CFP. 1659x2212: 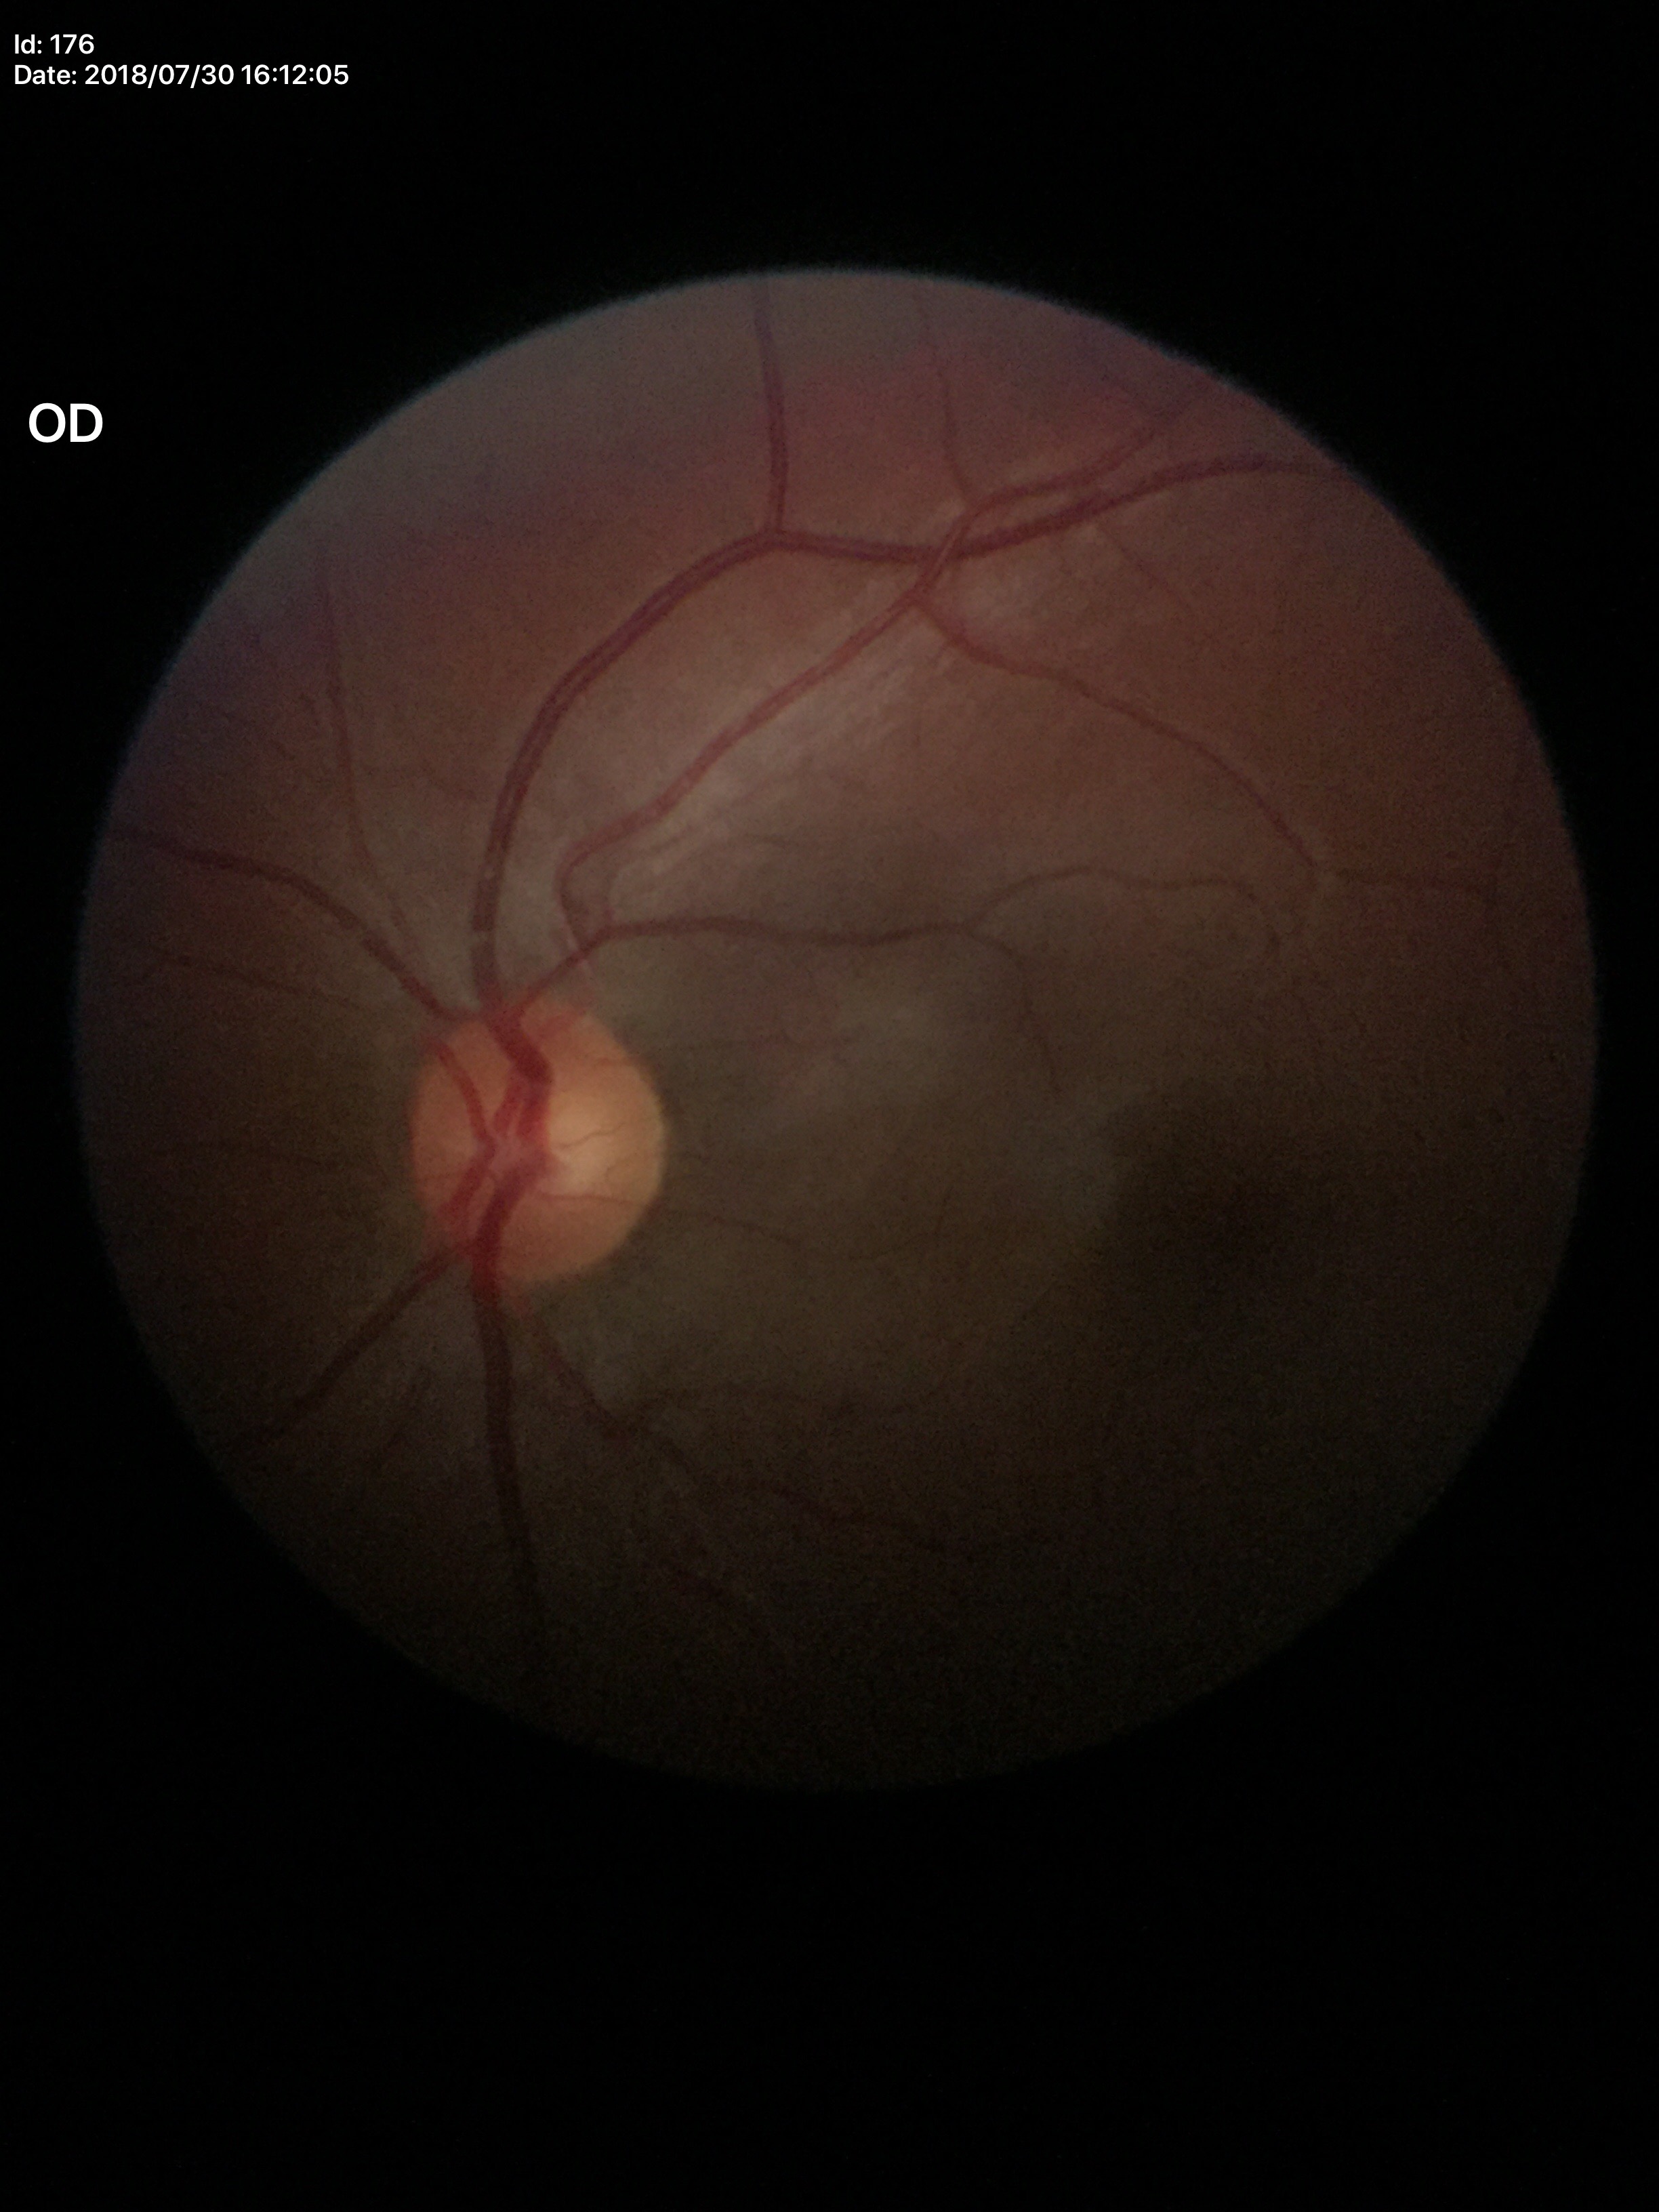

No glaucomatous optic neuropathy.
Vertical cup-disc ratio is 0.50.
Horizontal C/D ratio: 0.57.